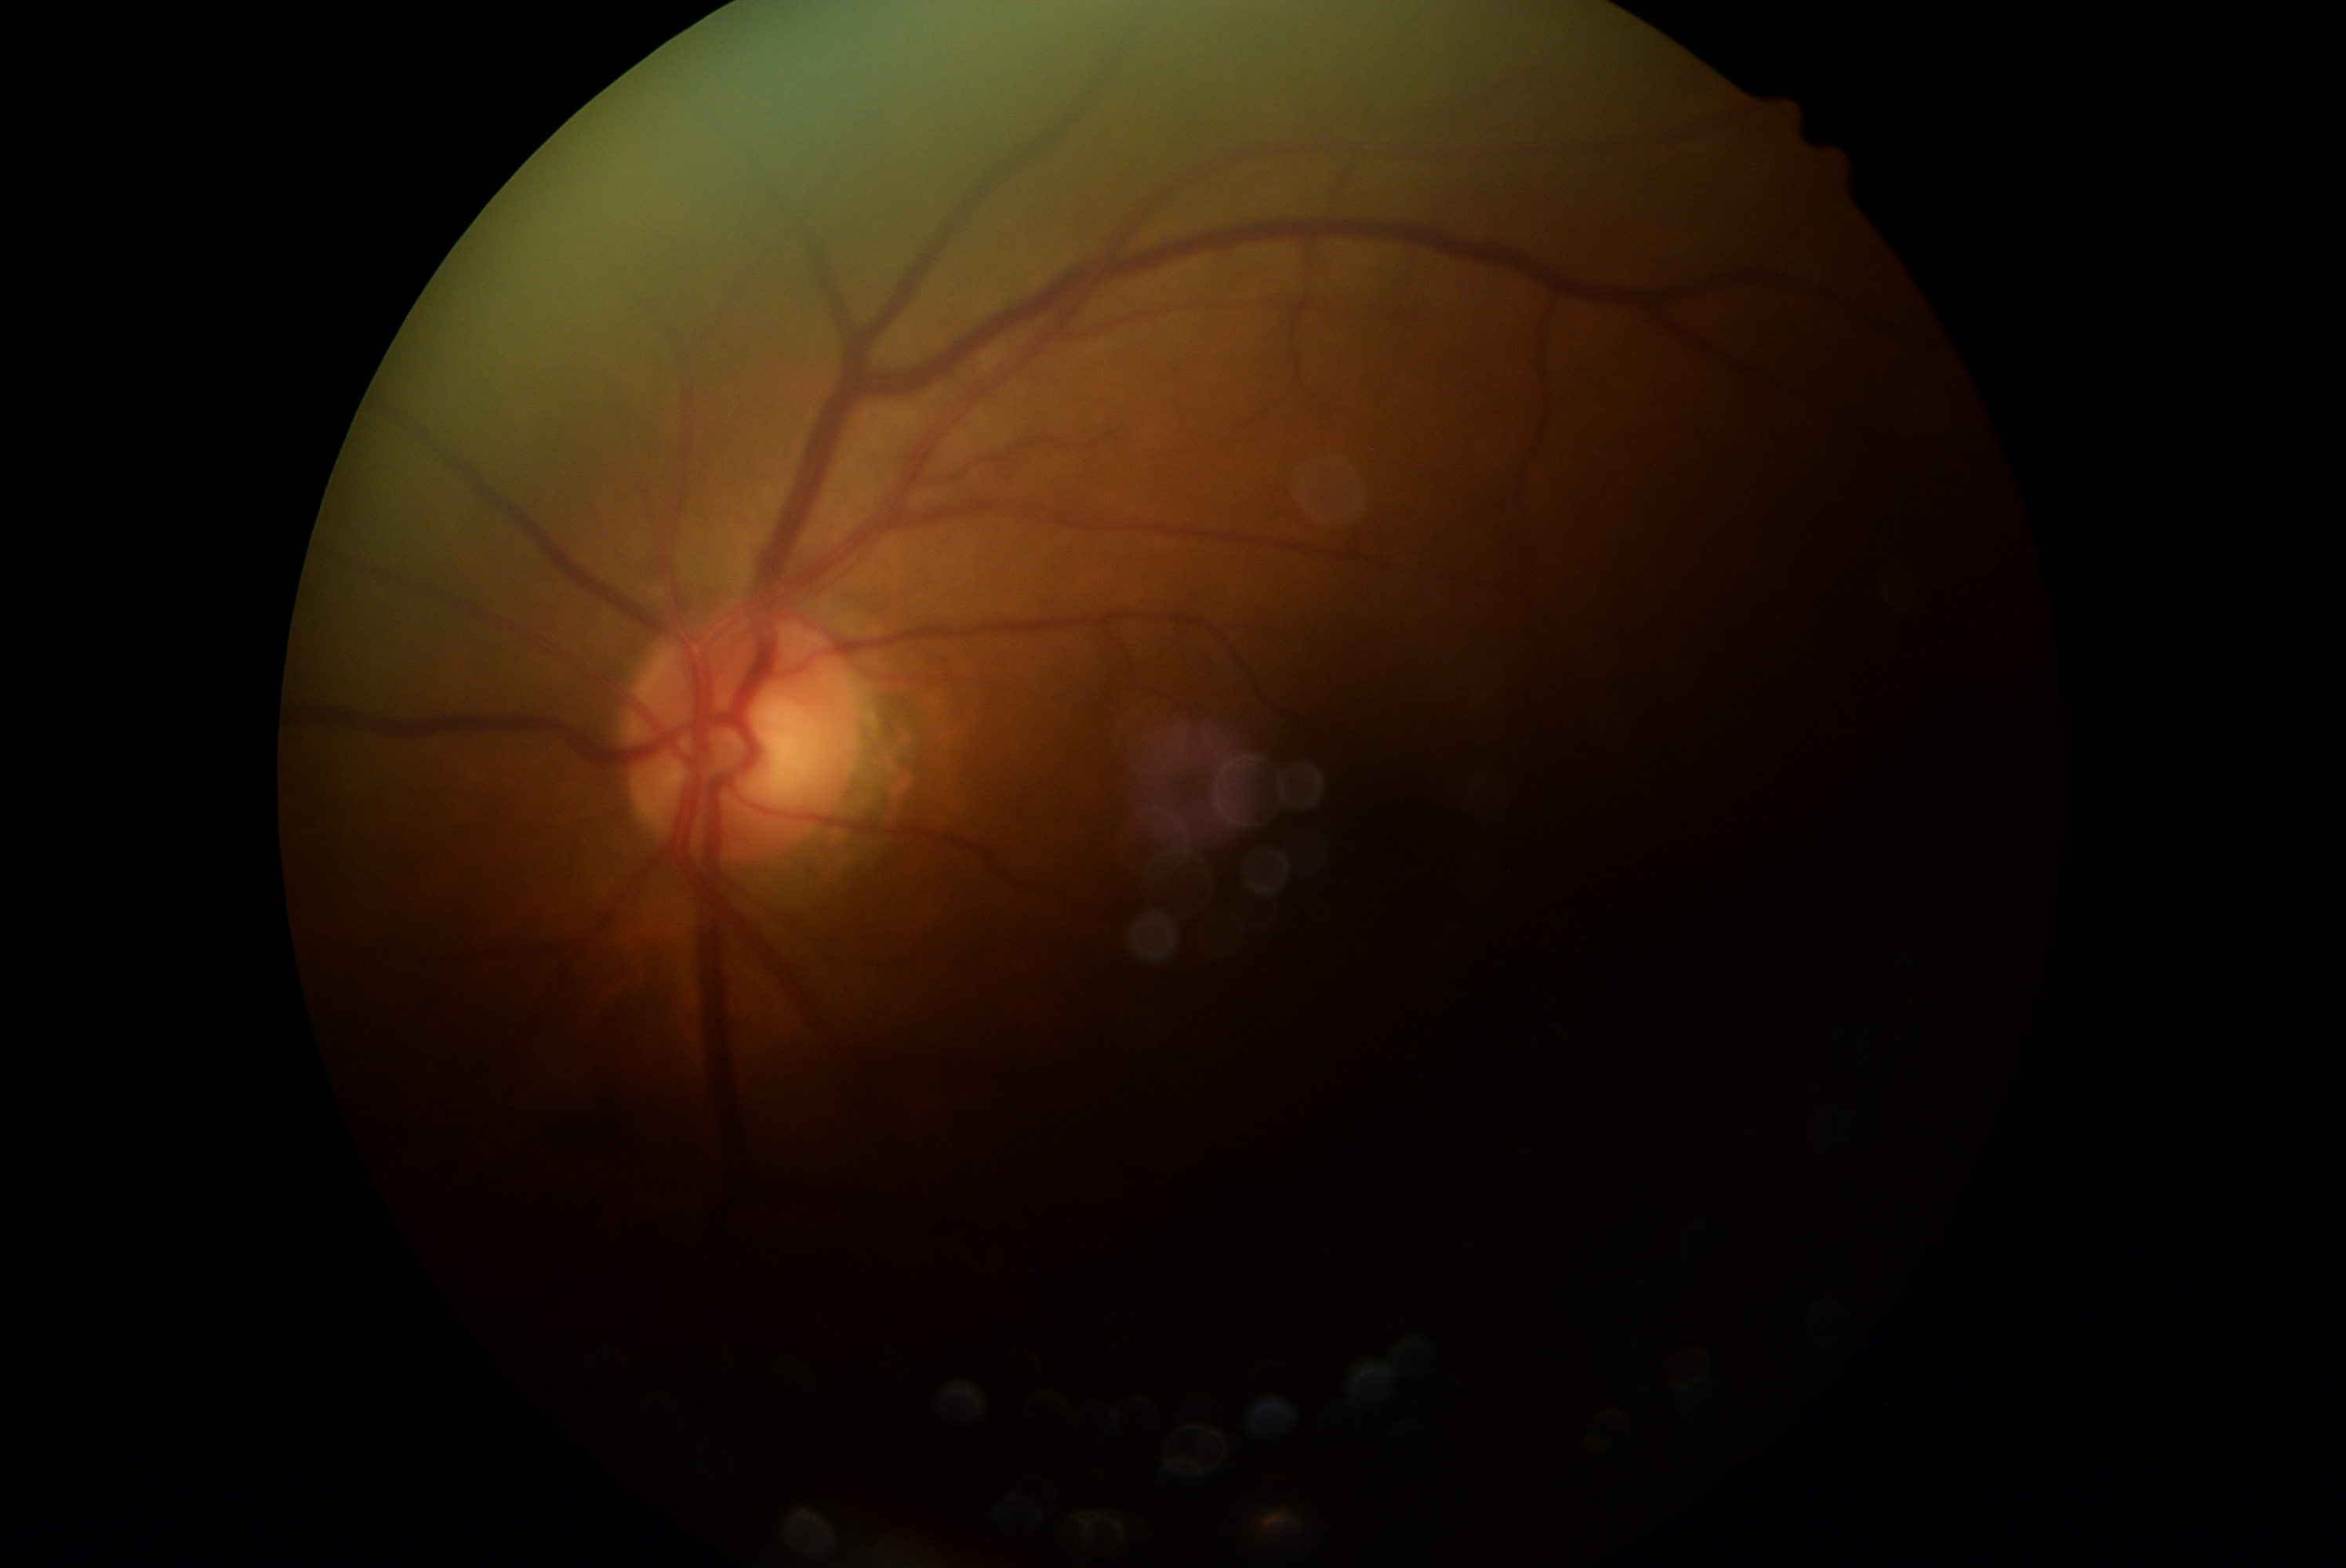

Retinopathy is ungradable.